Infant wide-field fundus photograph.
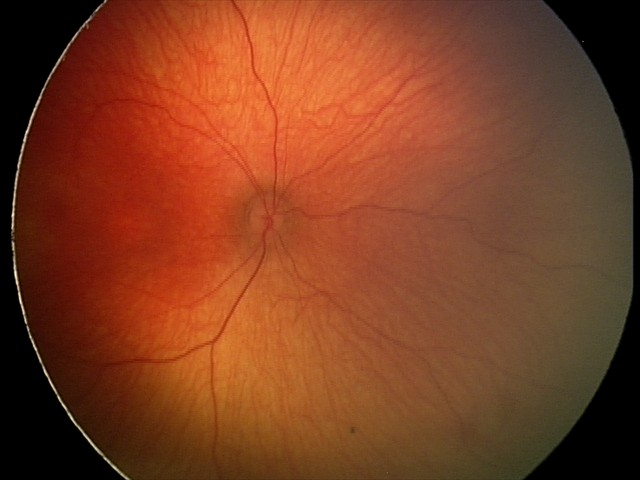
Diagnosis: physiological.